Infant wide-field retinal image — 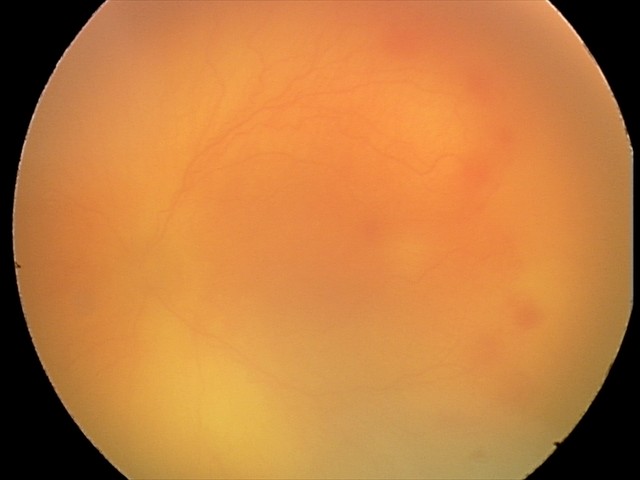 Finding: aggressive retinopathy of prematurity (A-ROP).